Davis DR grading — 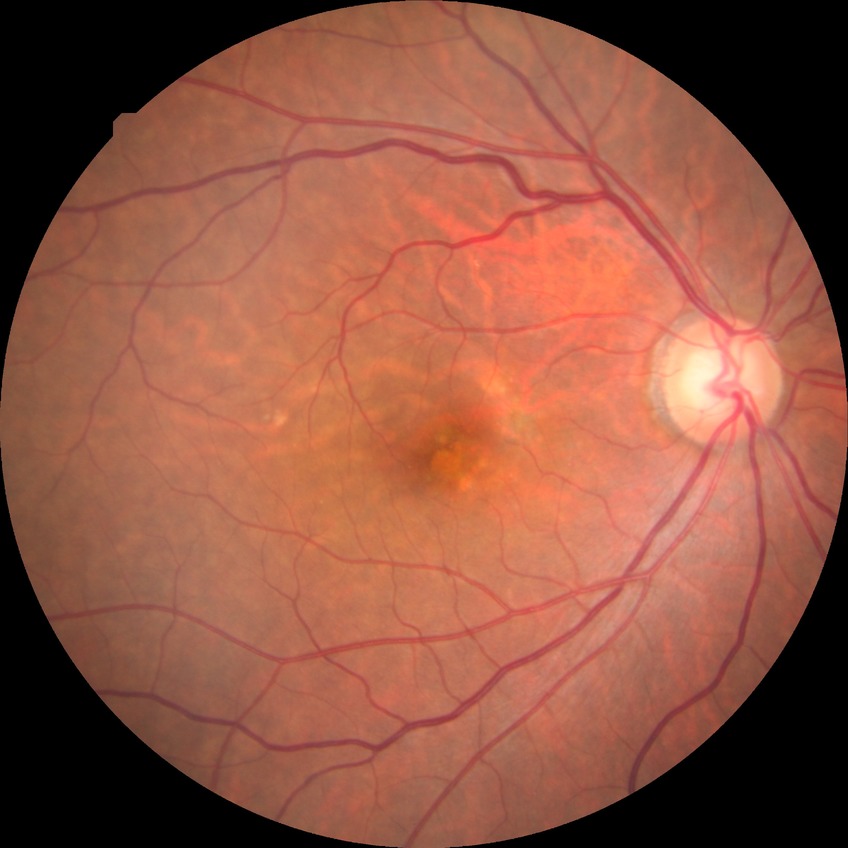

{
  "davis_grade": "no diabetic retinopathy (NDR)"
}